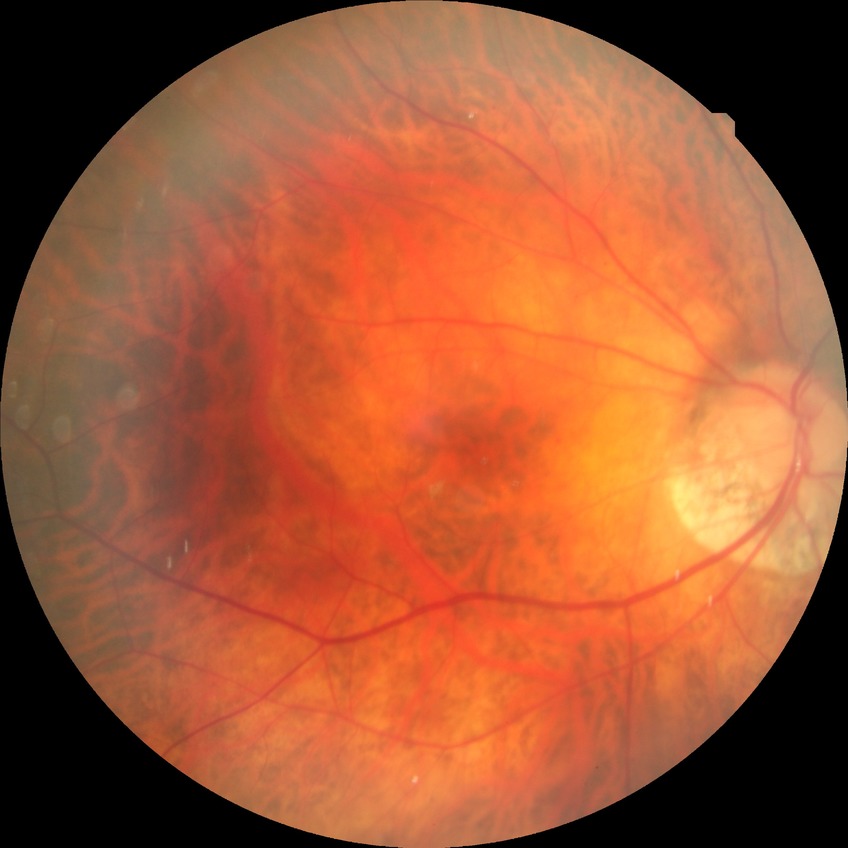
Diabetic retinopathy (DR) is no diabetic retinopathy (NDR).